130° field of view (Clarity RetCam 3). RetCam wide-field infant fundus image. 640 by 480 pixels — 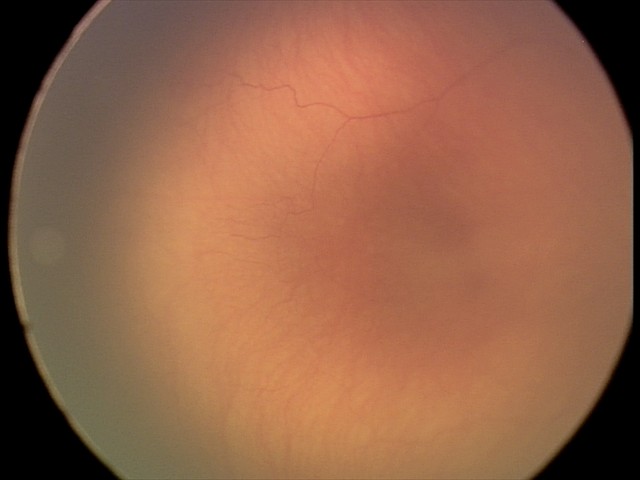 Assessment: ROP stage 0; no plus disease.